2352 x 1568 pixels — 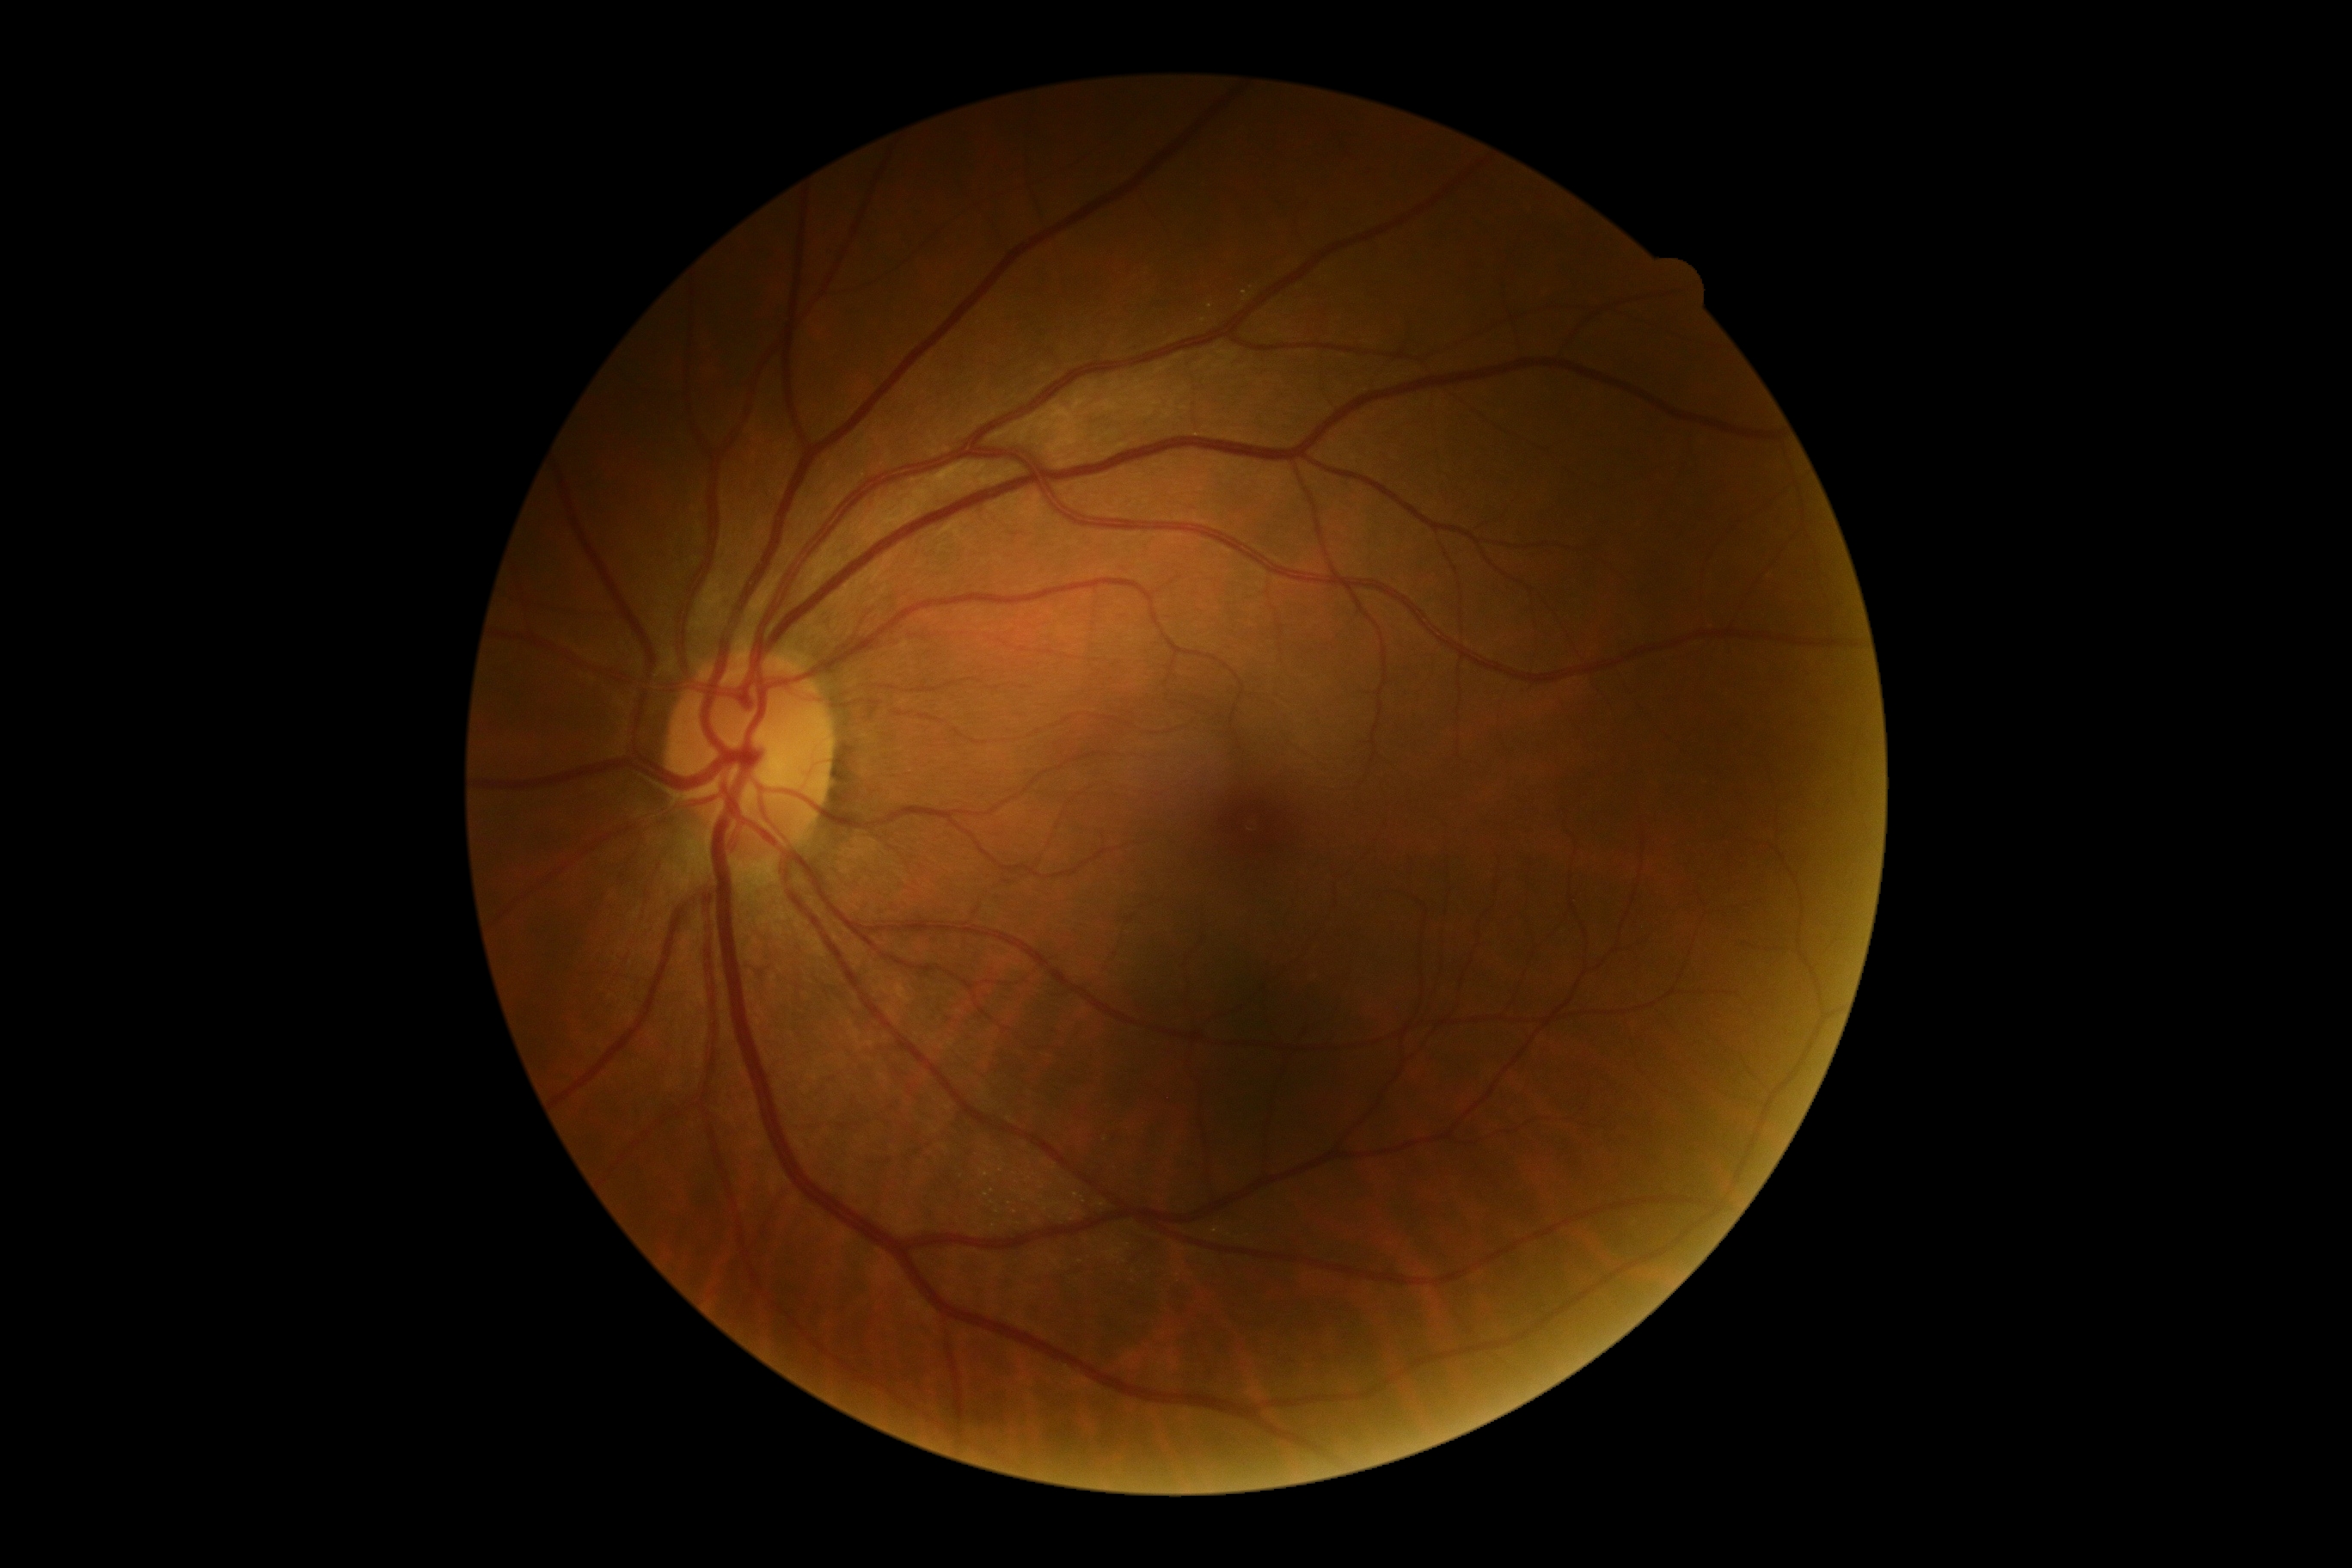
diabetic retinopathy (DR)@no apparent retinopathy (grade 0).